45° field of view — 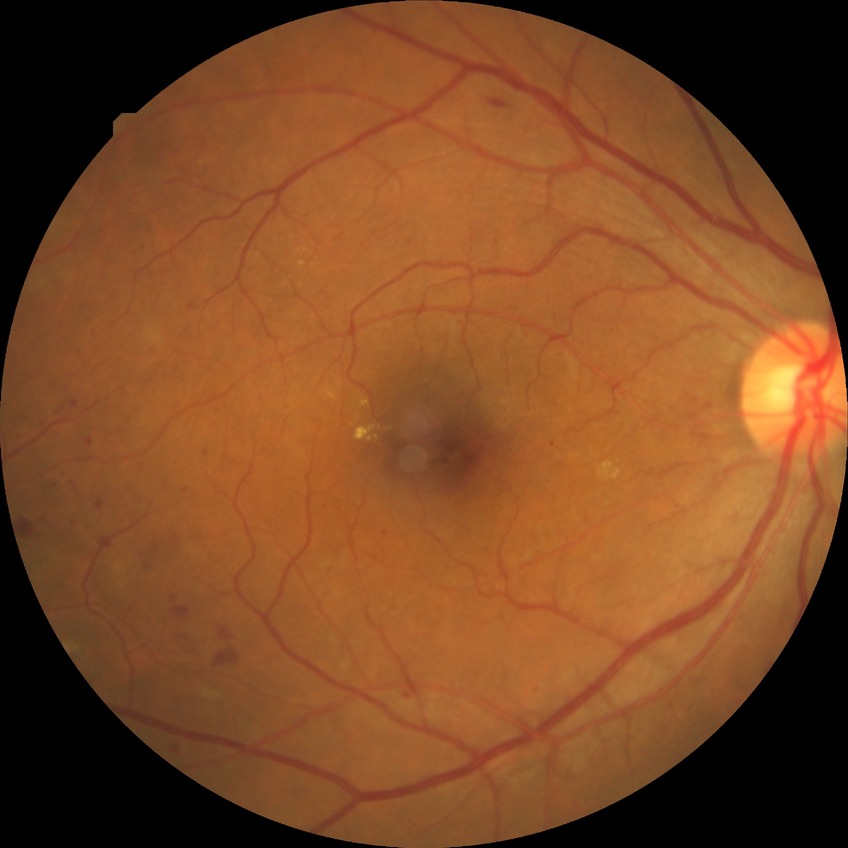

Assessment:
* Davis grading: proliferative diabetic retinopathy